Image size 640x480 · wide-field fundus image from infant ROP screening:
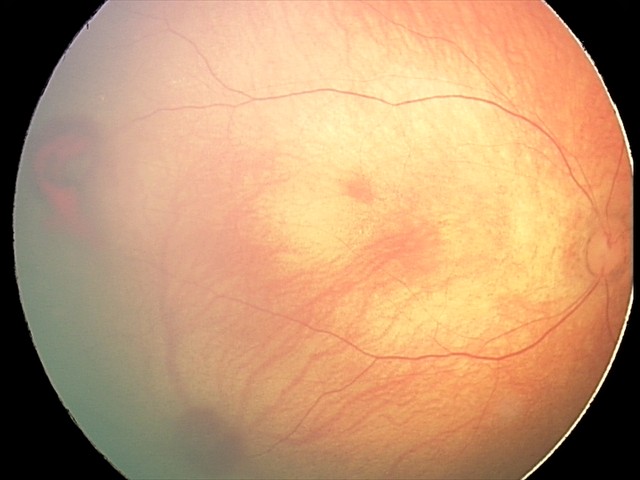 Examination diagnosed as retinal hemorrhages.